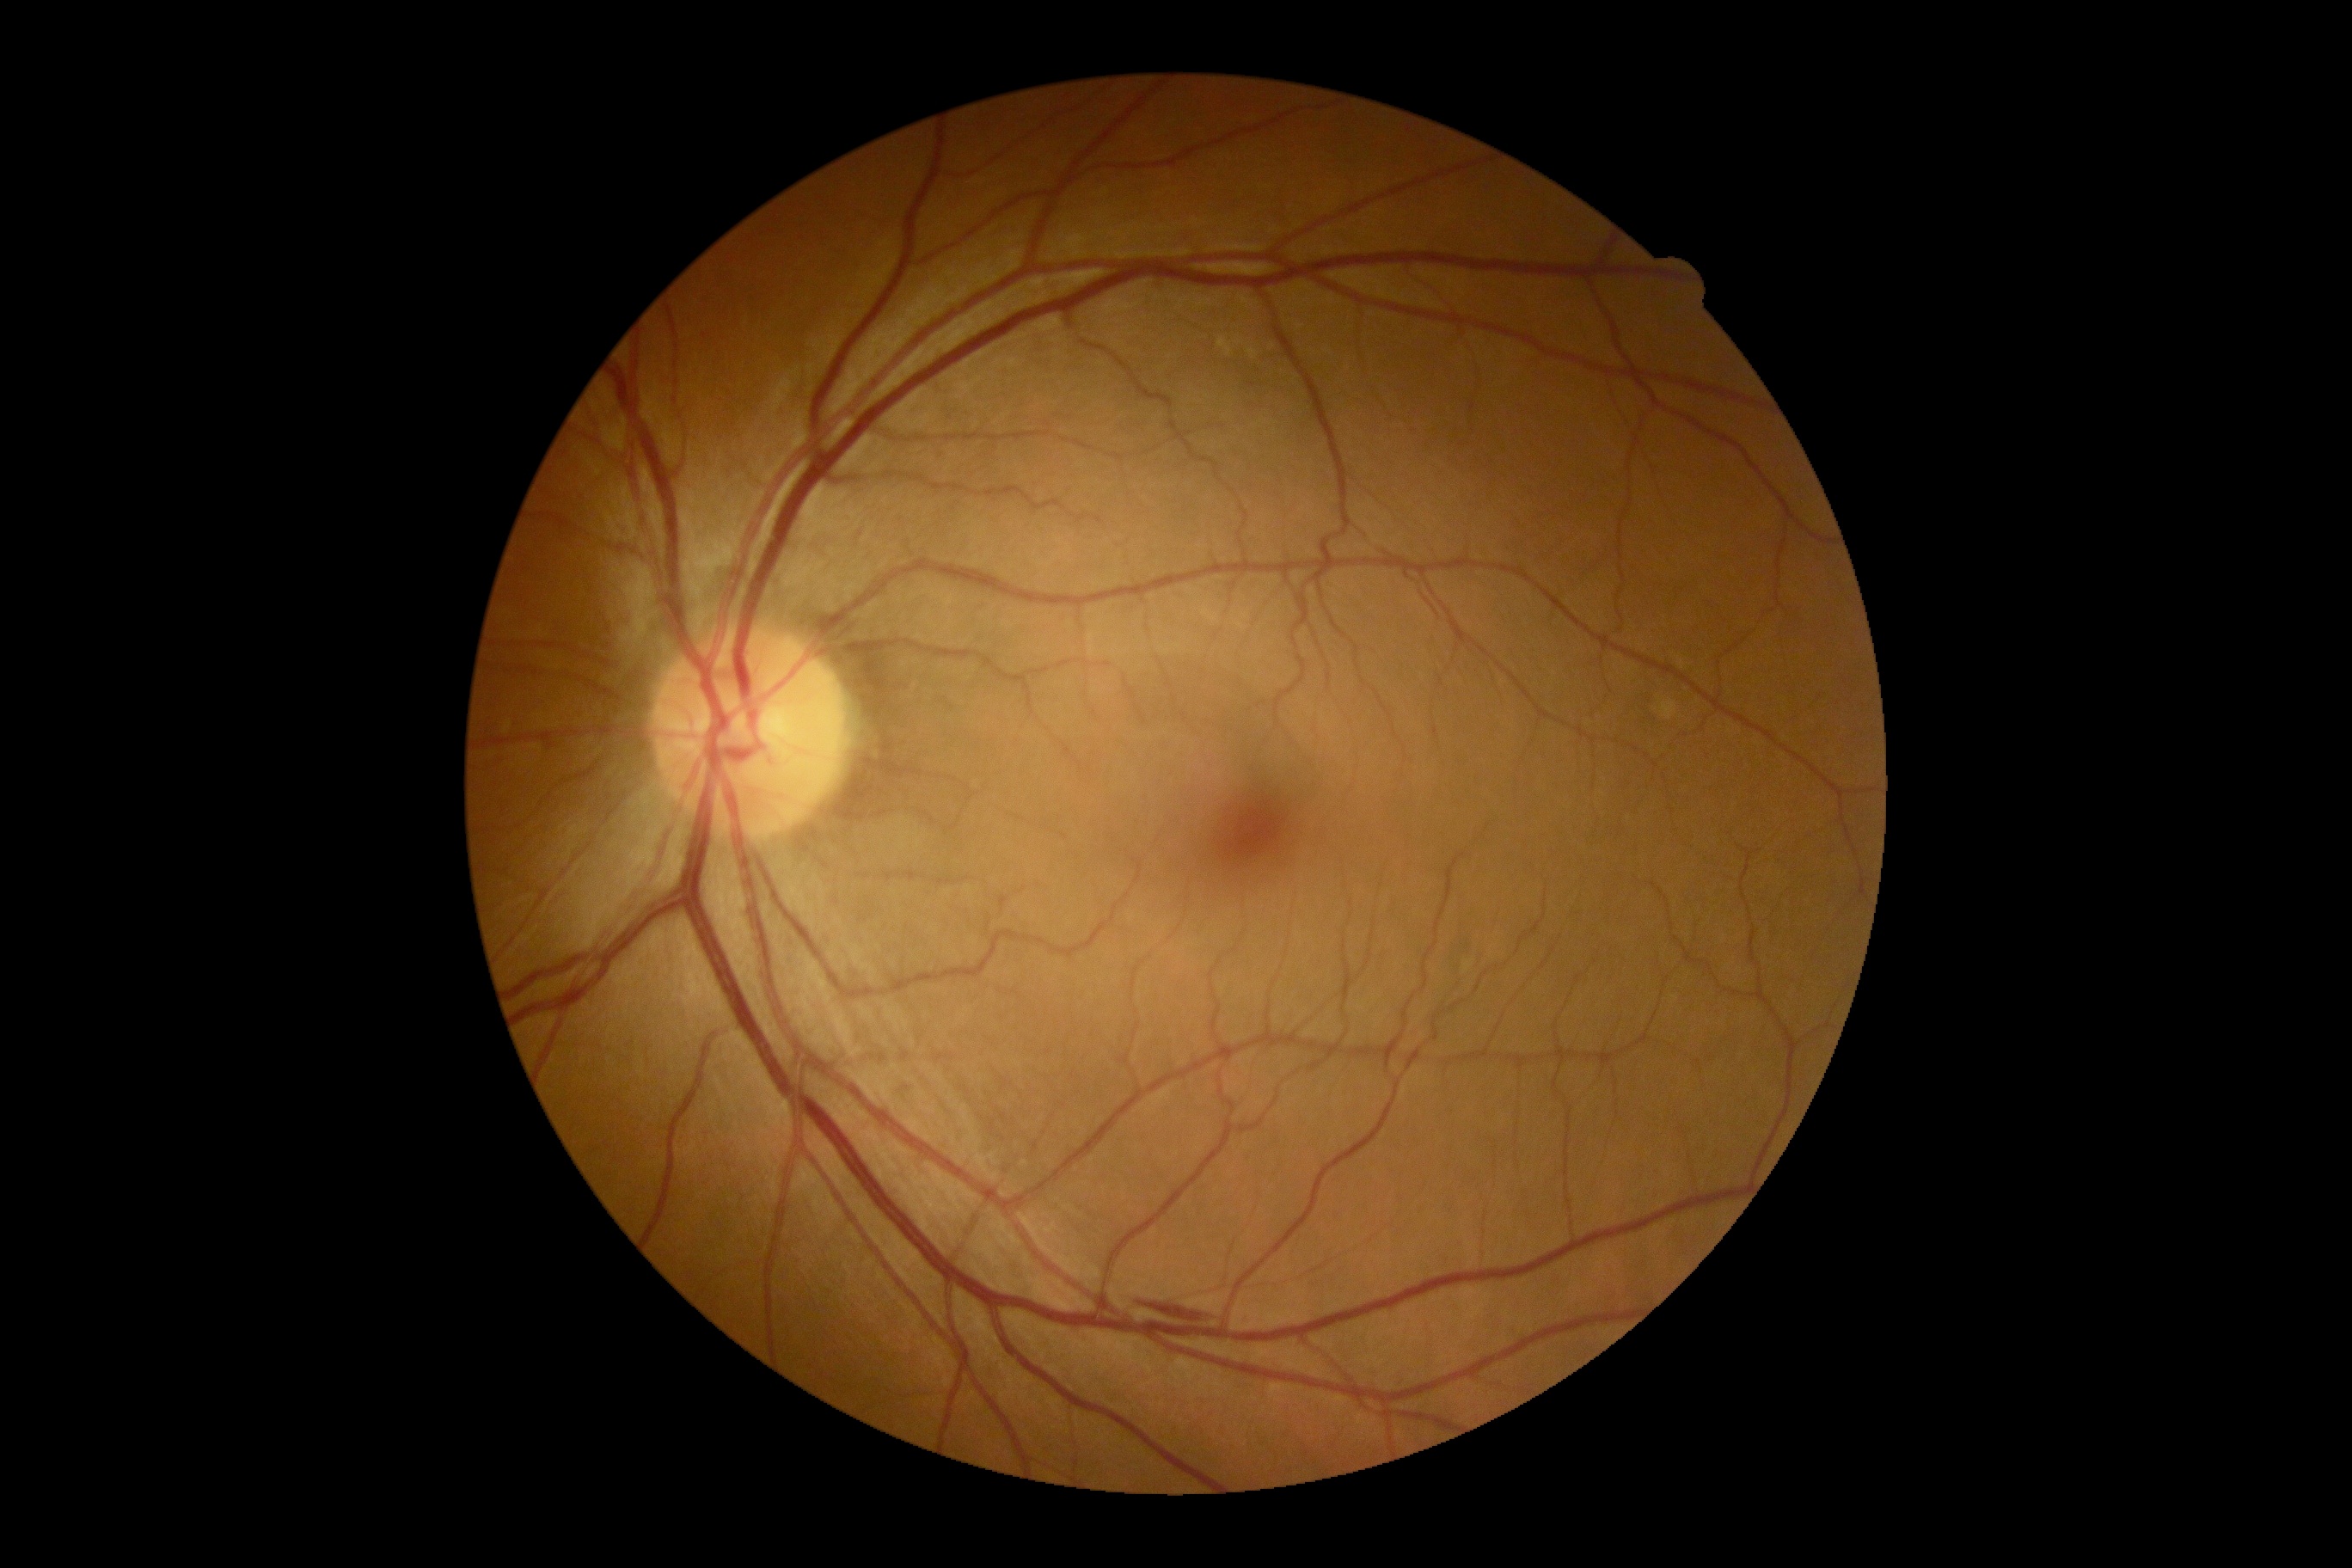 DR grade@2 (moderate NPDR).